Without pupil dilation; FOV: 45 degrees
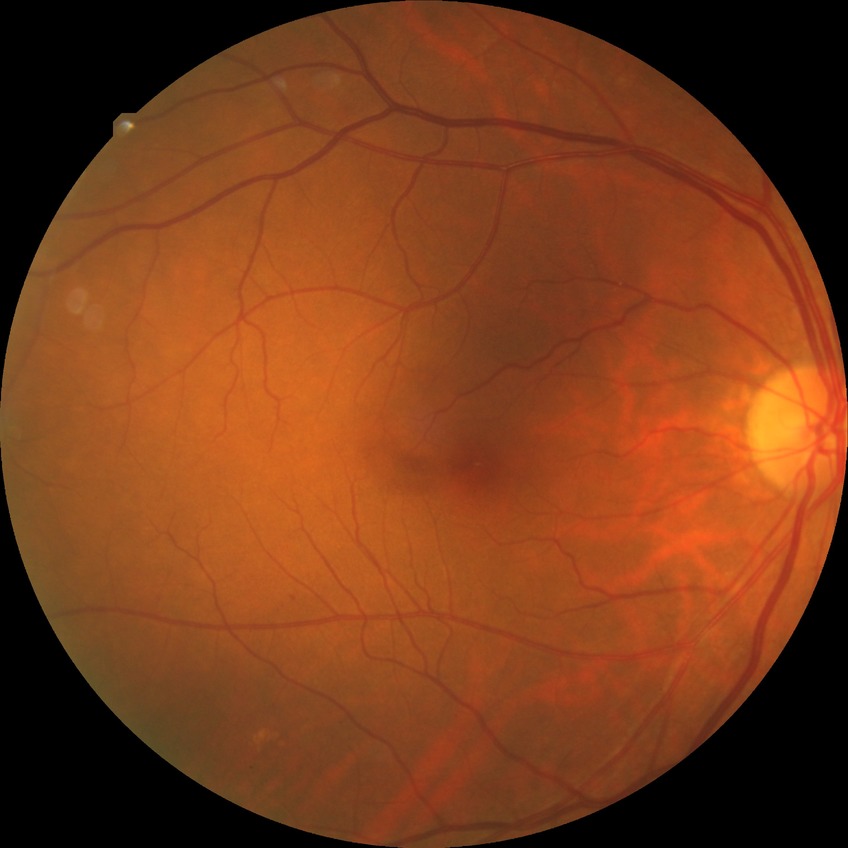

Diabetic retinopathy (DR): NDR (no diabetic retinopathy).